IOP: 11 mmHg; centered on the optic disc; visual field mean defect (MD): -0.09 dB; age 78; axial length (AL) 23.77 mm; non-mydriatic acquisition; female; pachymetry: 484 µm; refraction: +0.25 -1.25 x 30; color fundus photograph; 2212x1661px
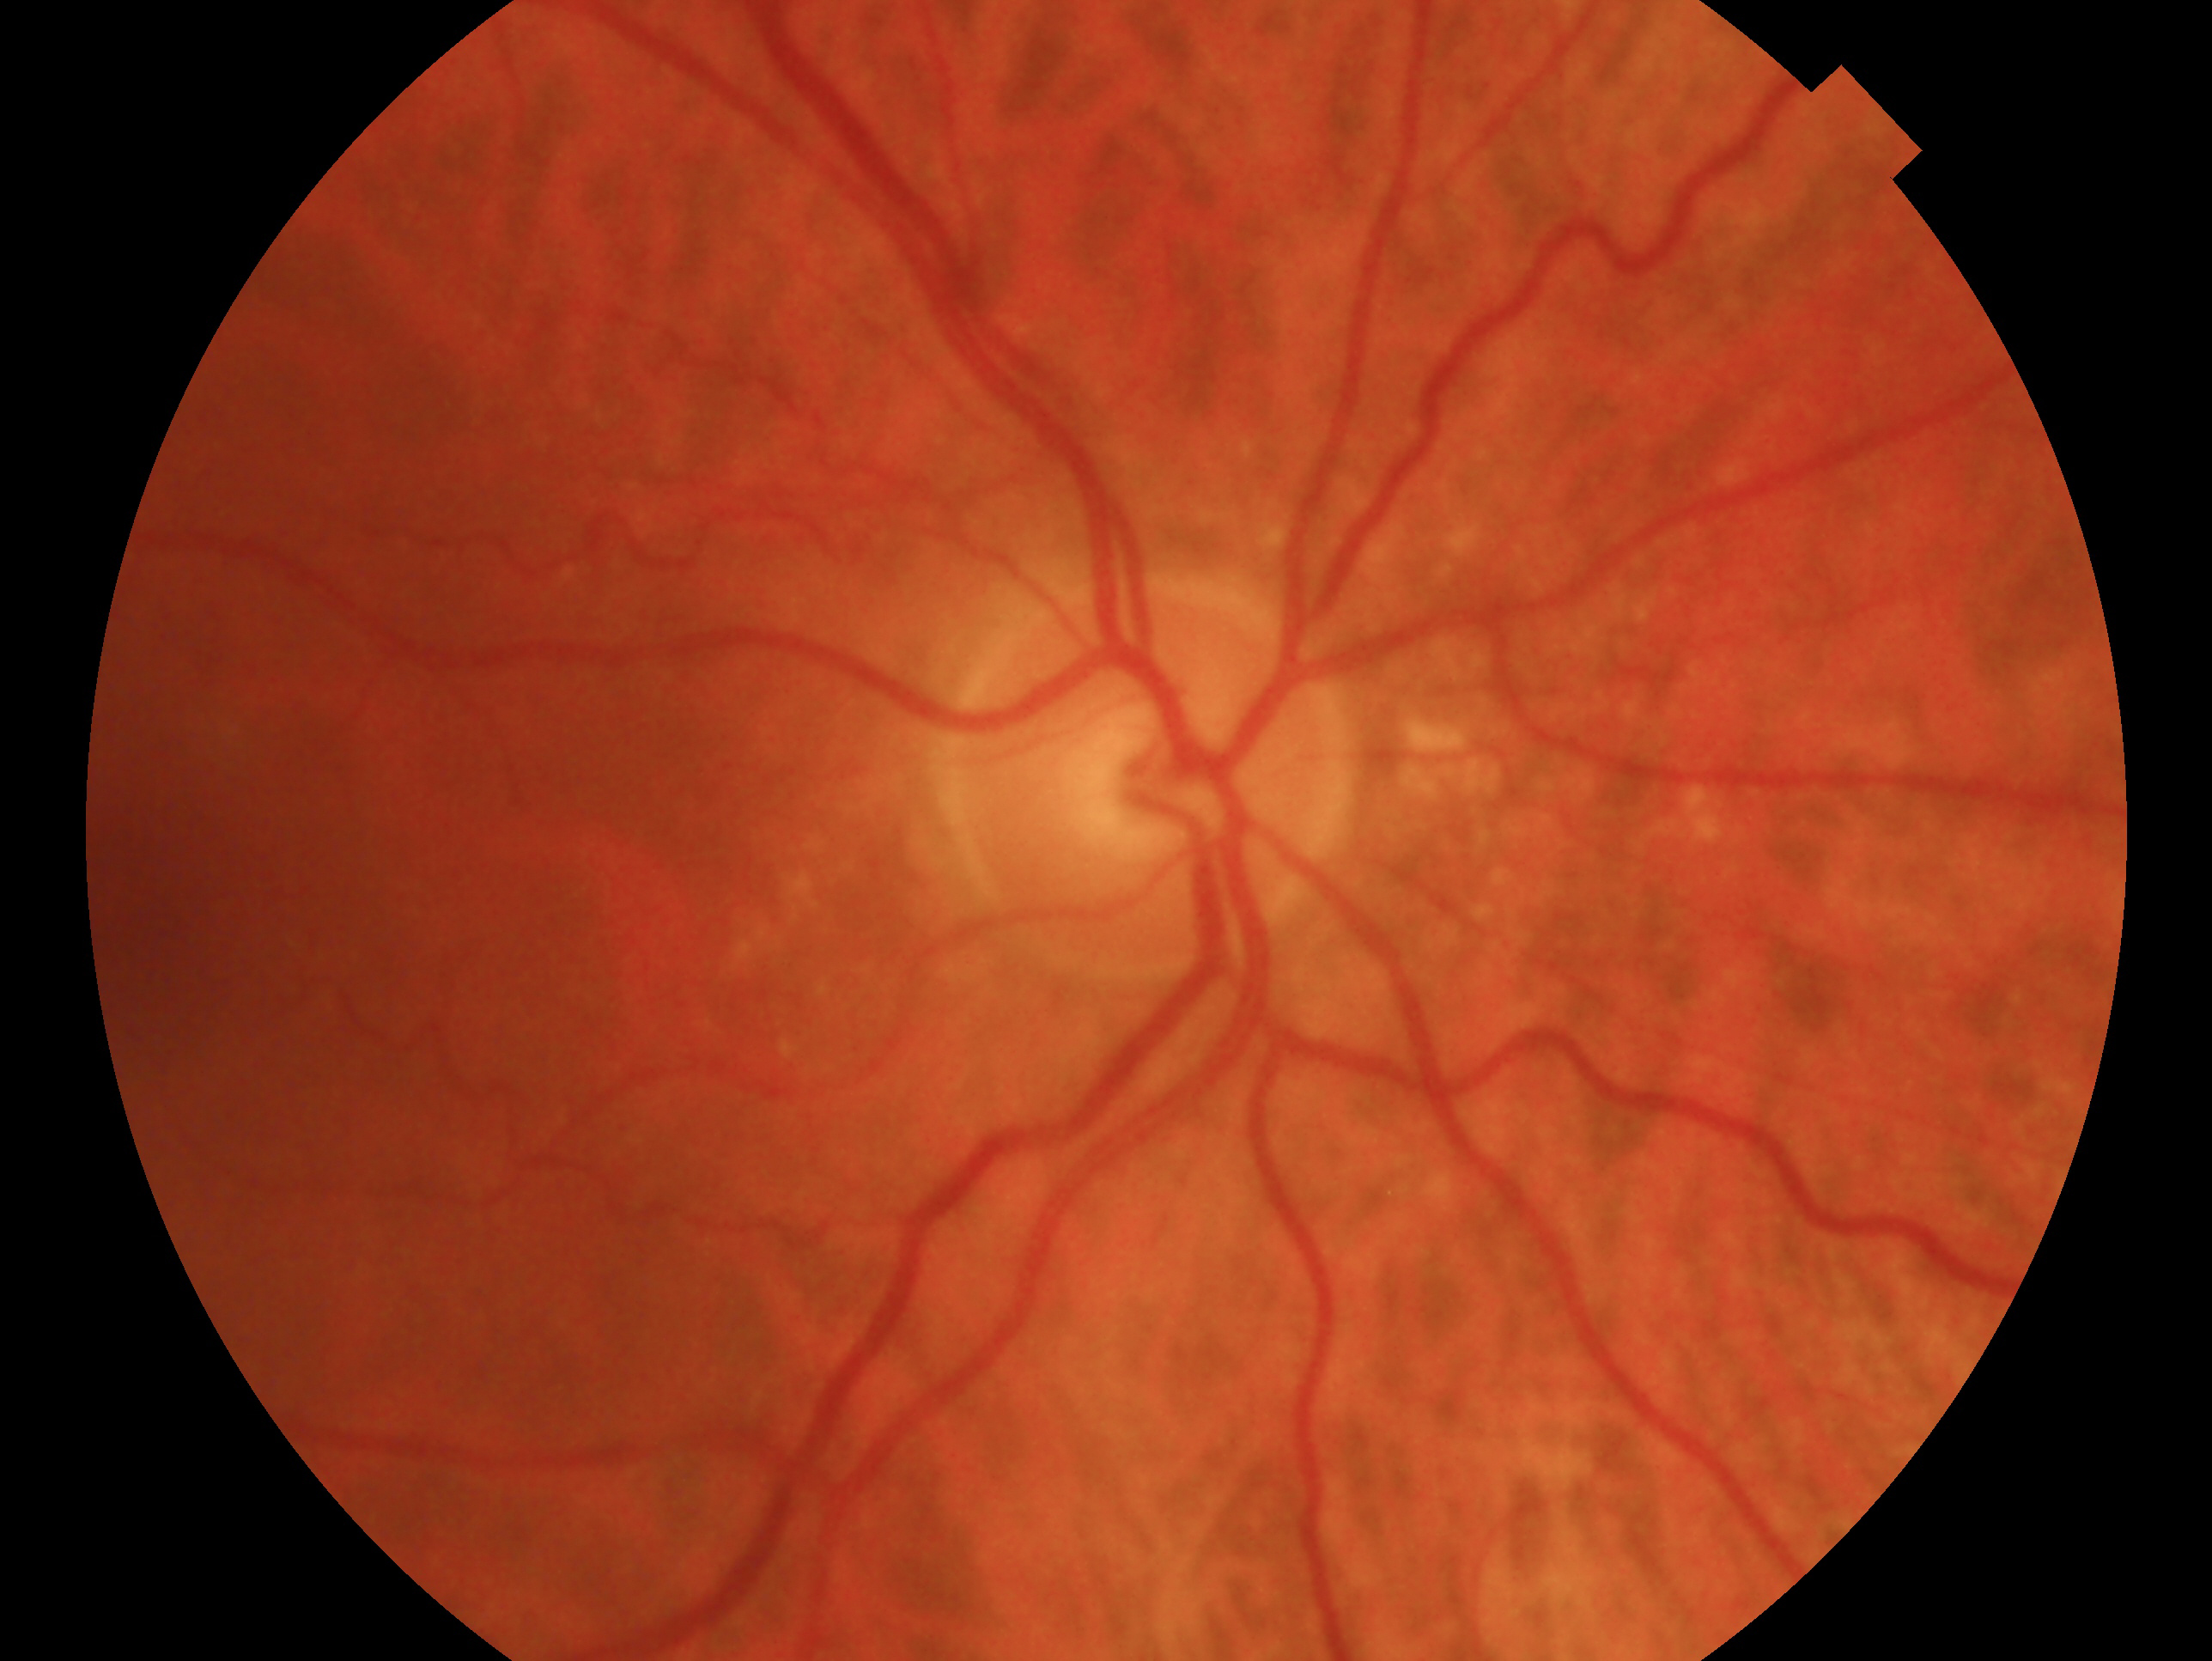 Glaucoma assessment: no signs of glaucoma.
Imaged eye: right eye.